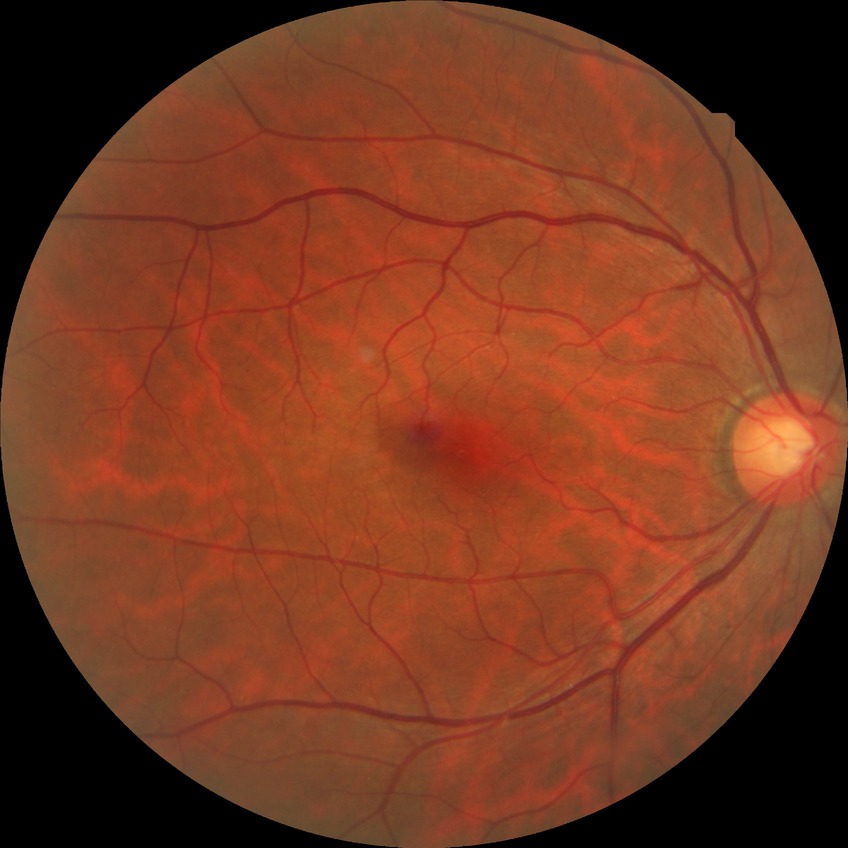
  davis_grade: no diabetic retinopathy